CFP; nonmydriatic fundus photograph; graded on the modified Davis scale; 45 degree fundus photograph; 848x848px — 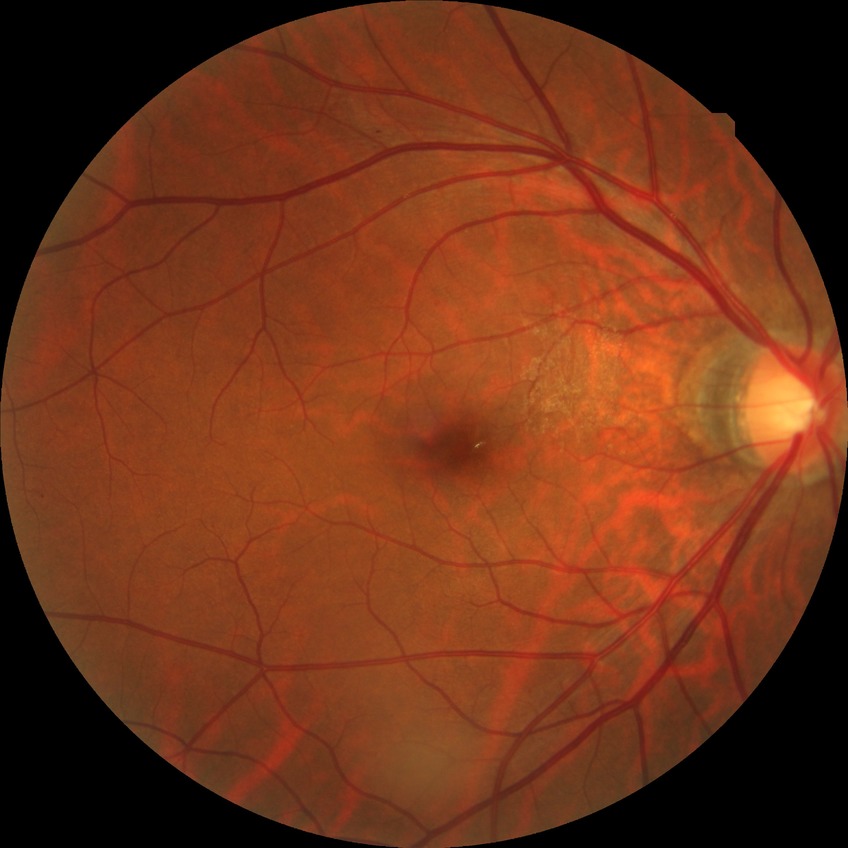 Davis stage: SDR. The retinopathy is classified as non-proliferative diabetic retinopathy.